1932 by 1932 pixels — 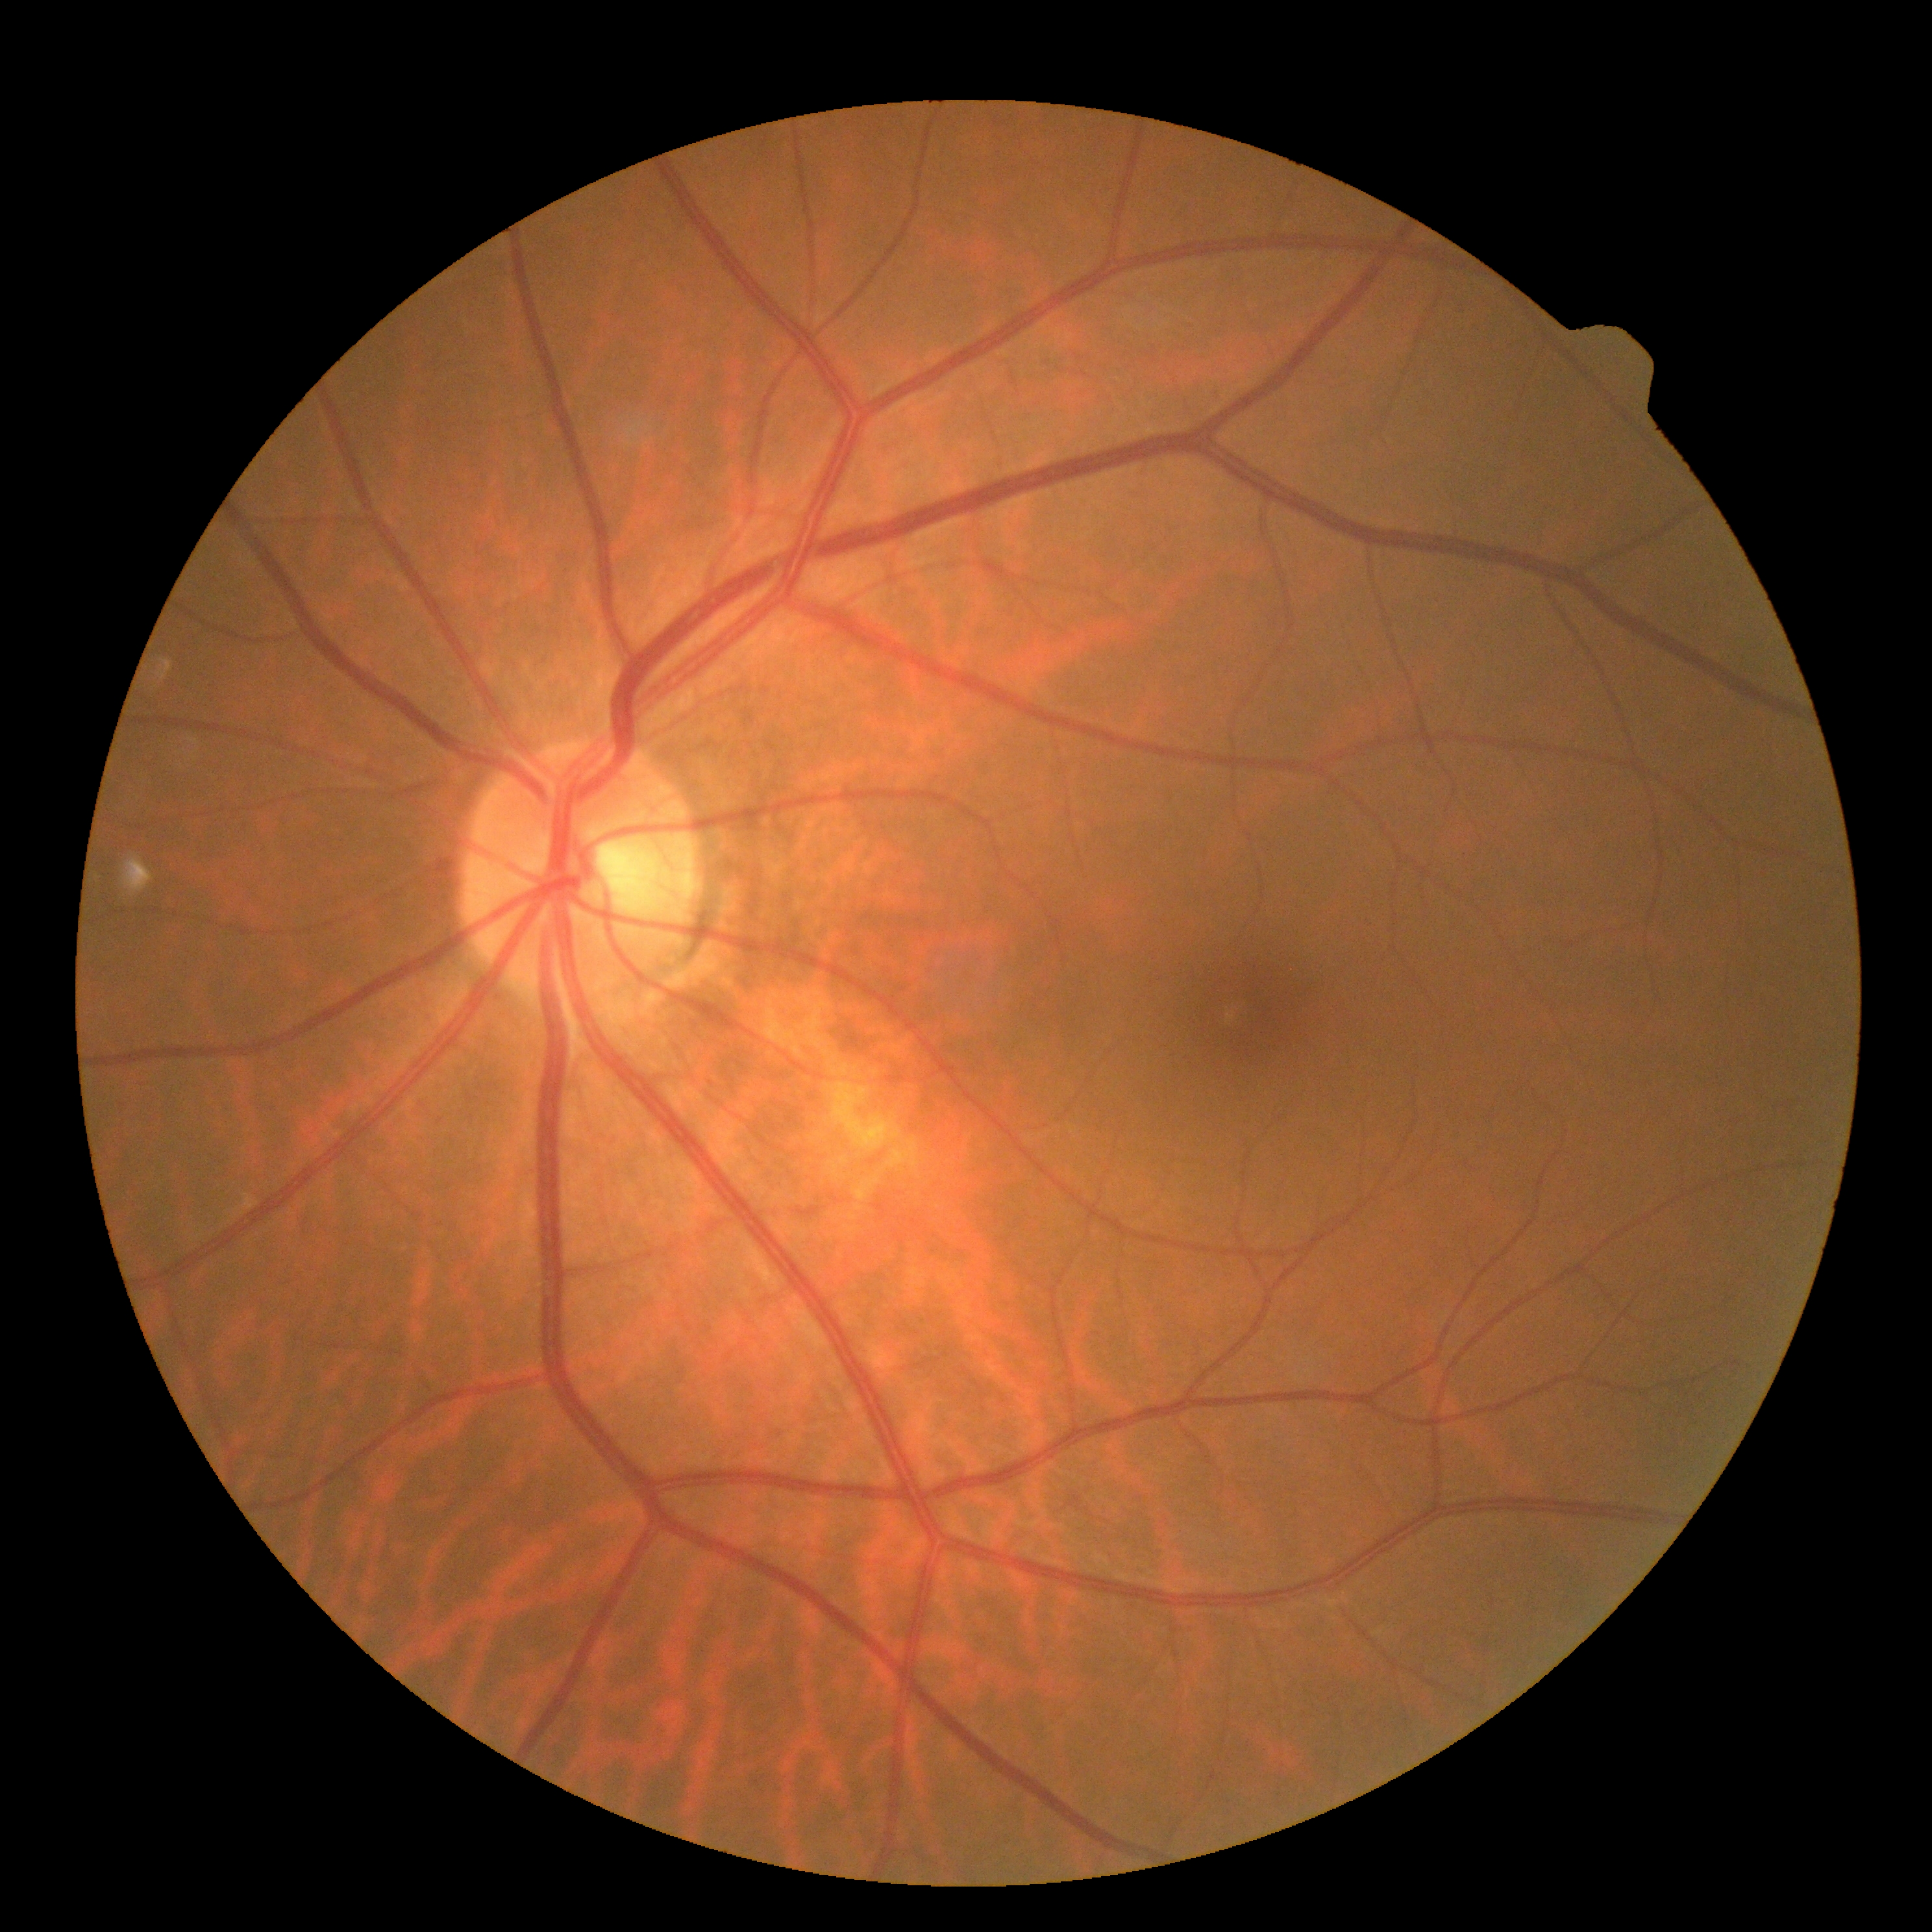 Diabetic retinopathy severity is grade 0.